Acquired on the Natus RetCam Envision · pediatric wide-field fundus photograph
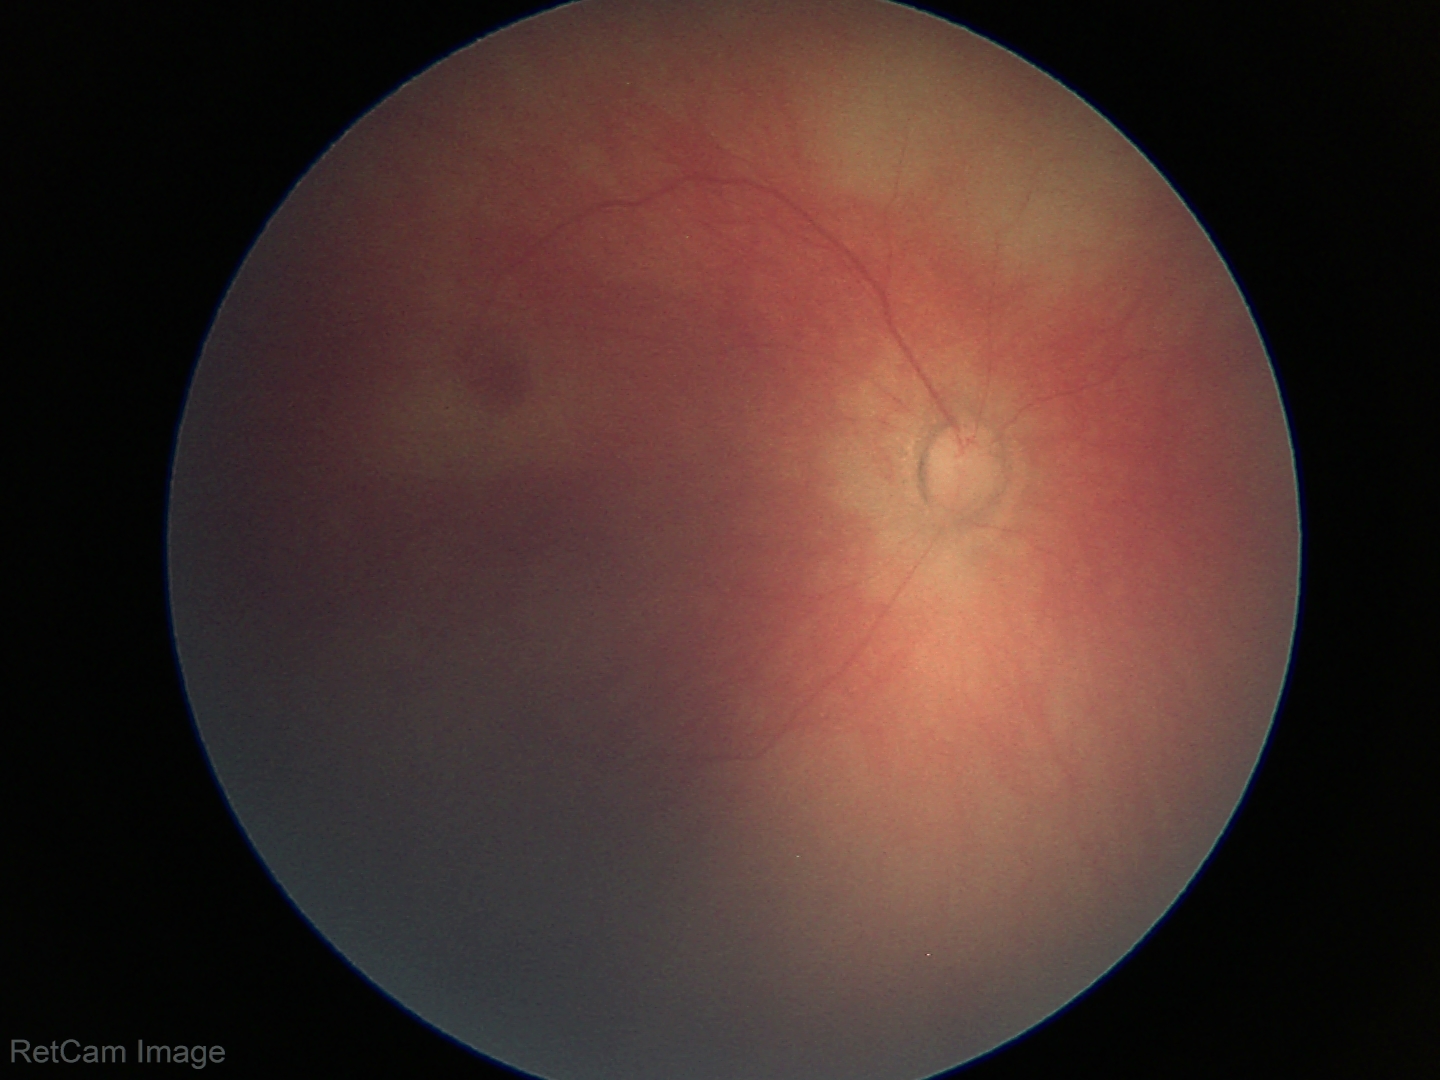
Q: What was the screening finding?
A: physiological retinal finding